45° field of view.
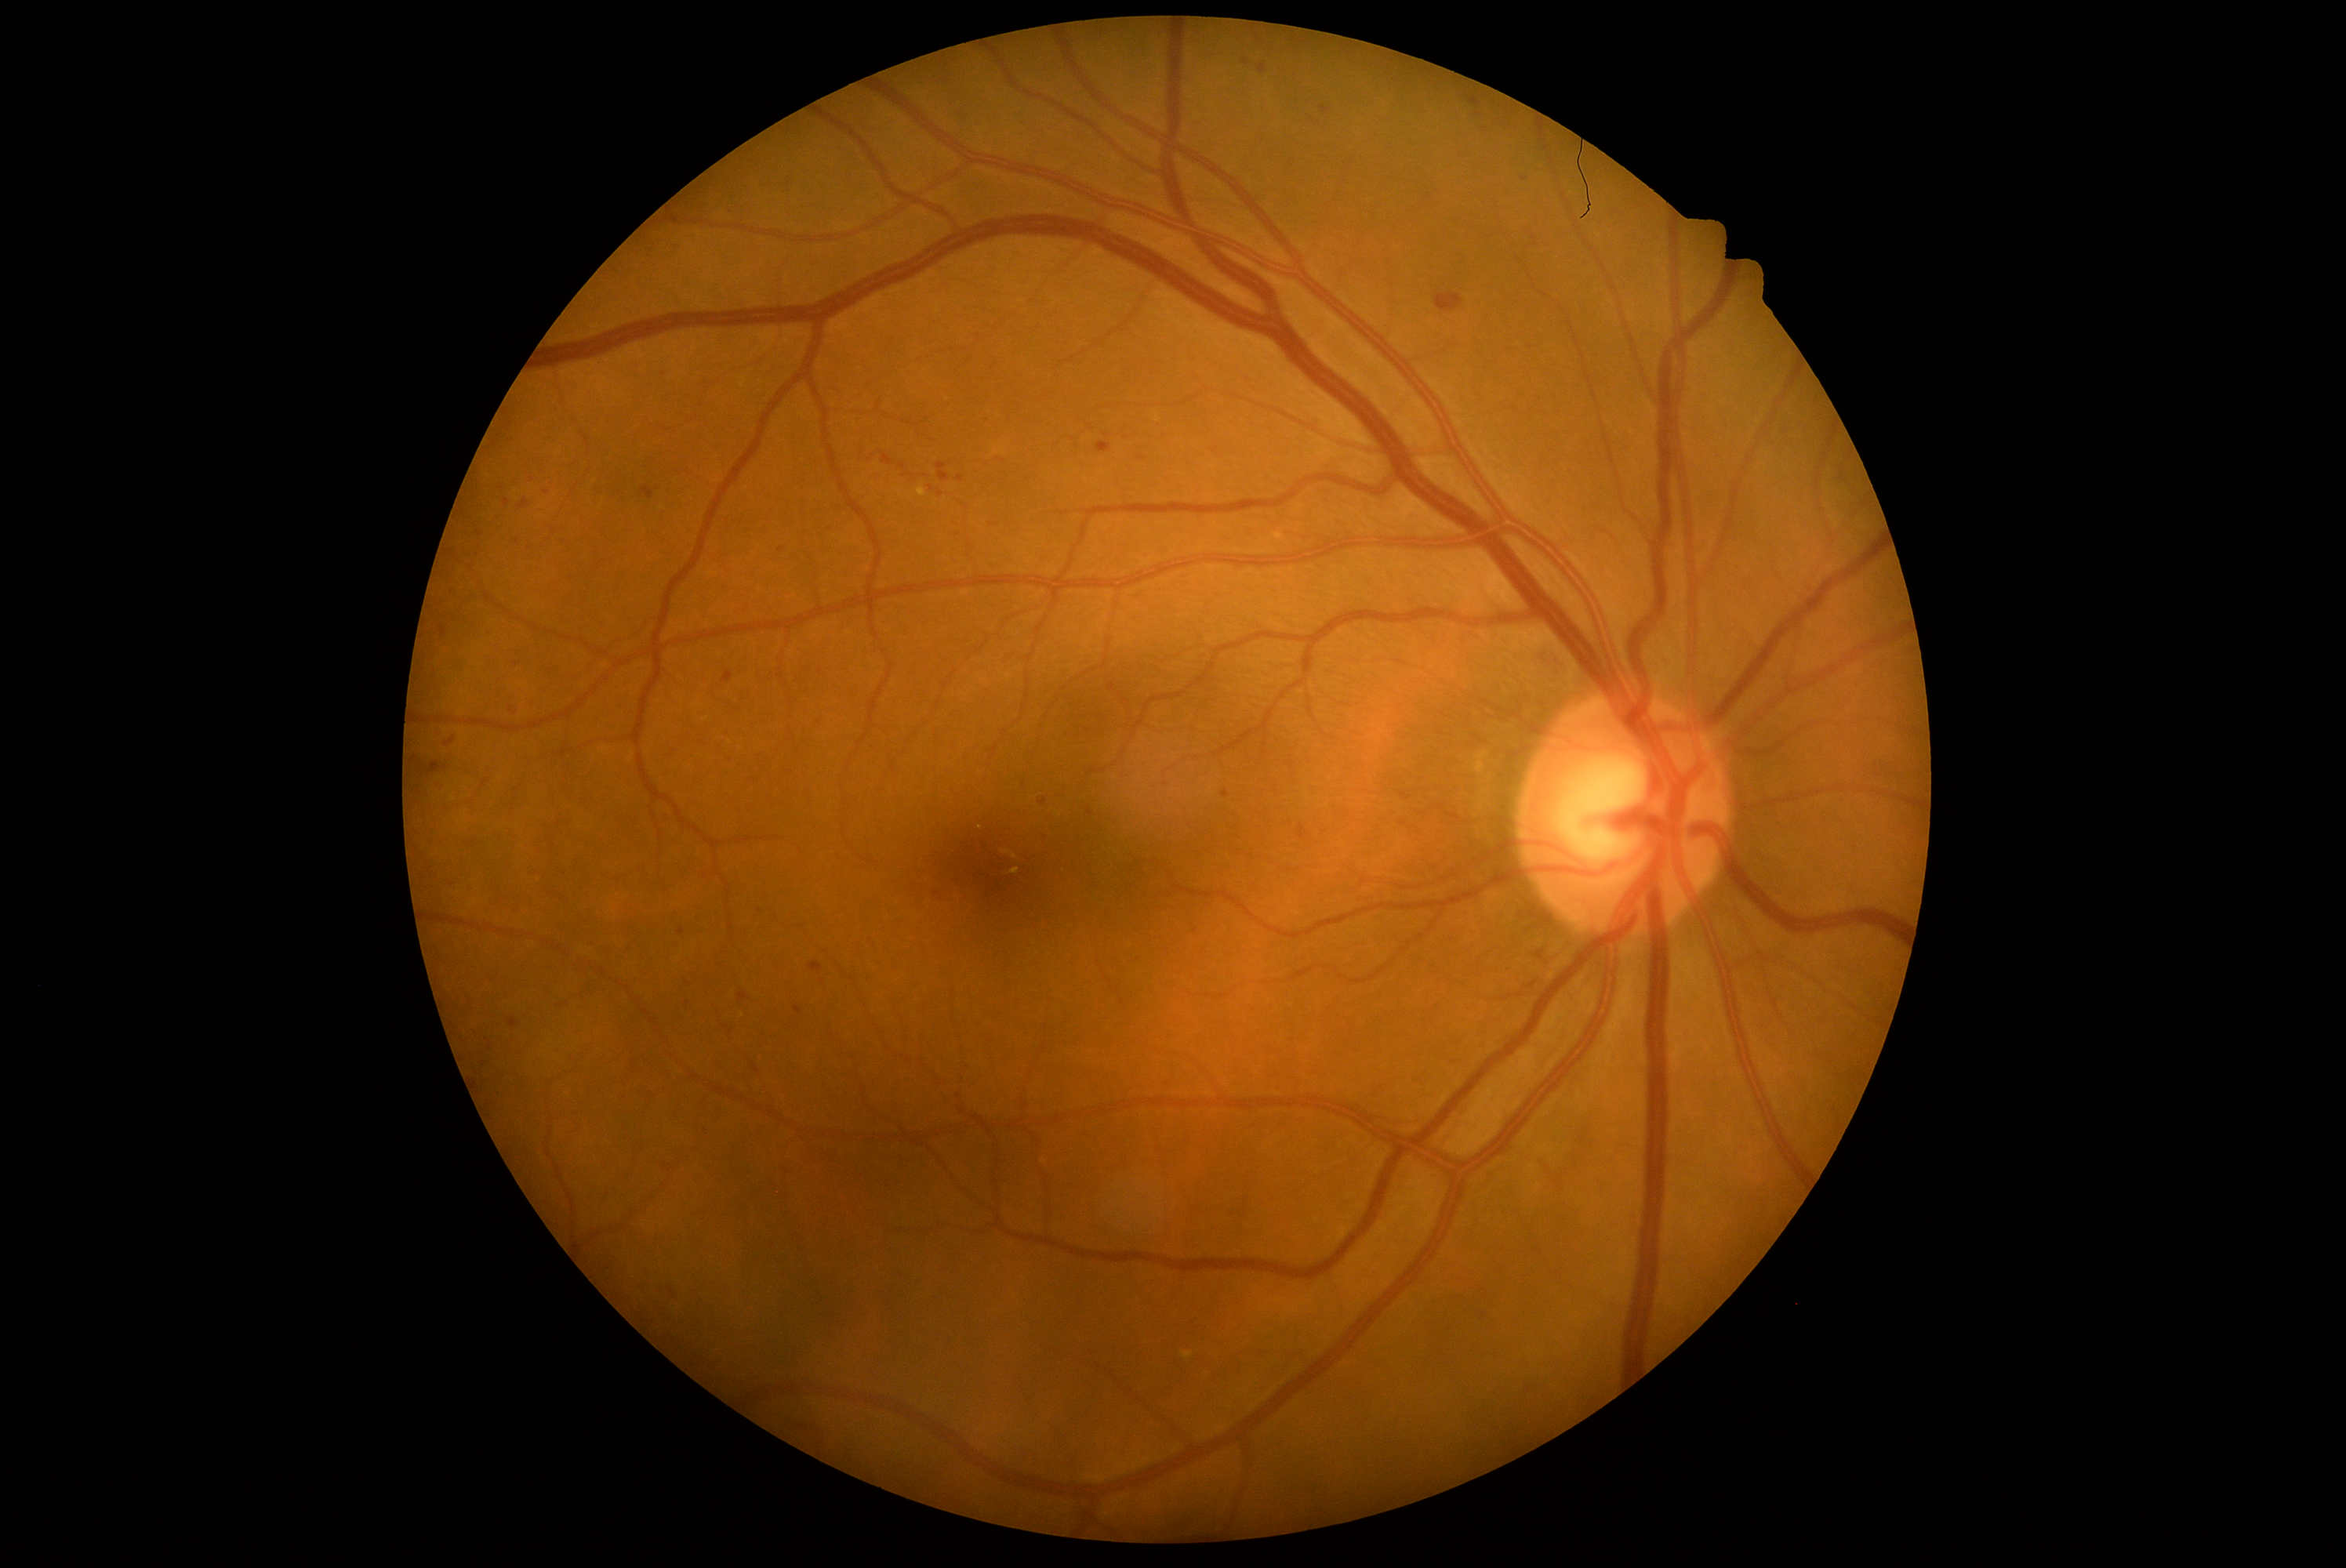 Diabetic retinopathy (DR) is 2/4
Lesions identified (partial list):
hemorrhages (HEs) (more not shown): bbox=(655, 1283, 680, 1302), bbox=(463, 885, 474, 895), bbox=(1480, 126, 1491, 136), bbox=(1400, 793, 1411, 800), bbox=(948, 529, 965, 540), bbox=(810, 962, 823, 973), bbox=(1055, 782, 1070, 800), bbox=(1258, 64, 1266, 73), bbox=(510, 706, 517, 716), bbox=(620, 940, 634, 956), bbox=(642, 487, 655, 499), bbox=(939, 490, 943, 498), bbox=(794, 1007, 802, 1014)
Small HEs approximately at <point>1142, 458</point>, <point>687, 983</point>, <point>1246, 63</point>, <point>480, 534</point>